Graded on the modified Davis scale · CFP.
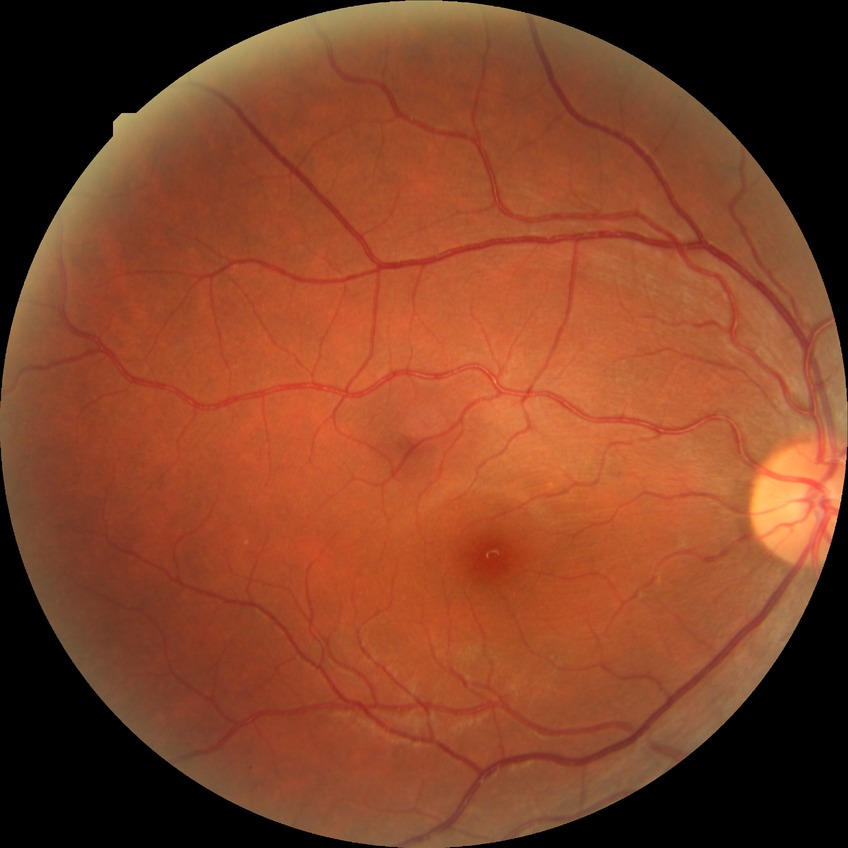
diabetic retinopathy severity = no diabetic retinopathy.